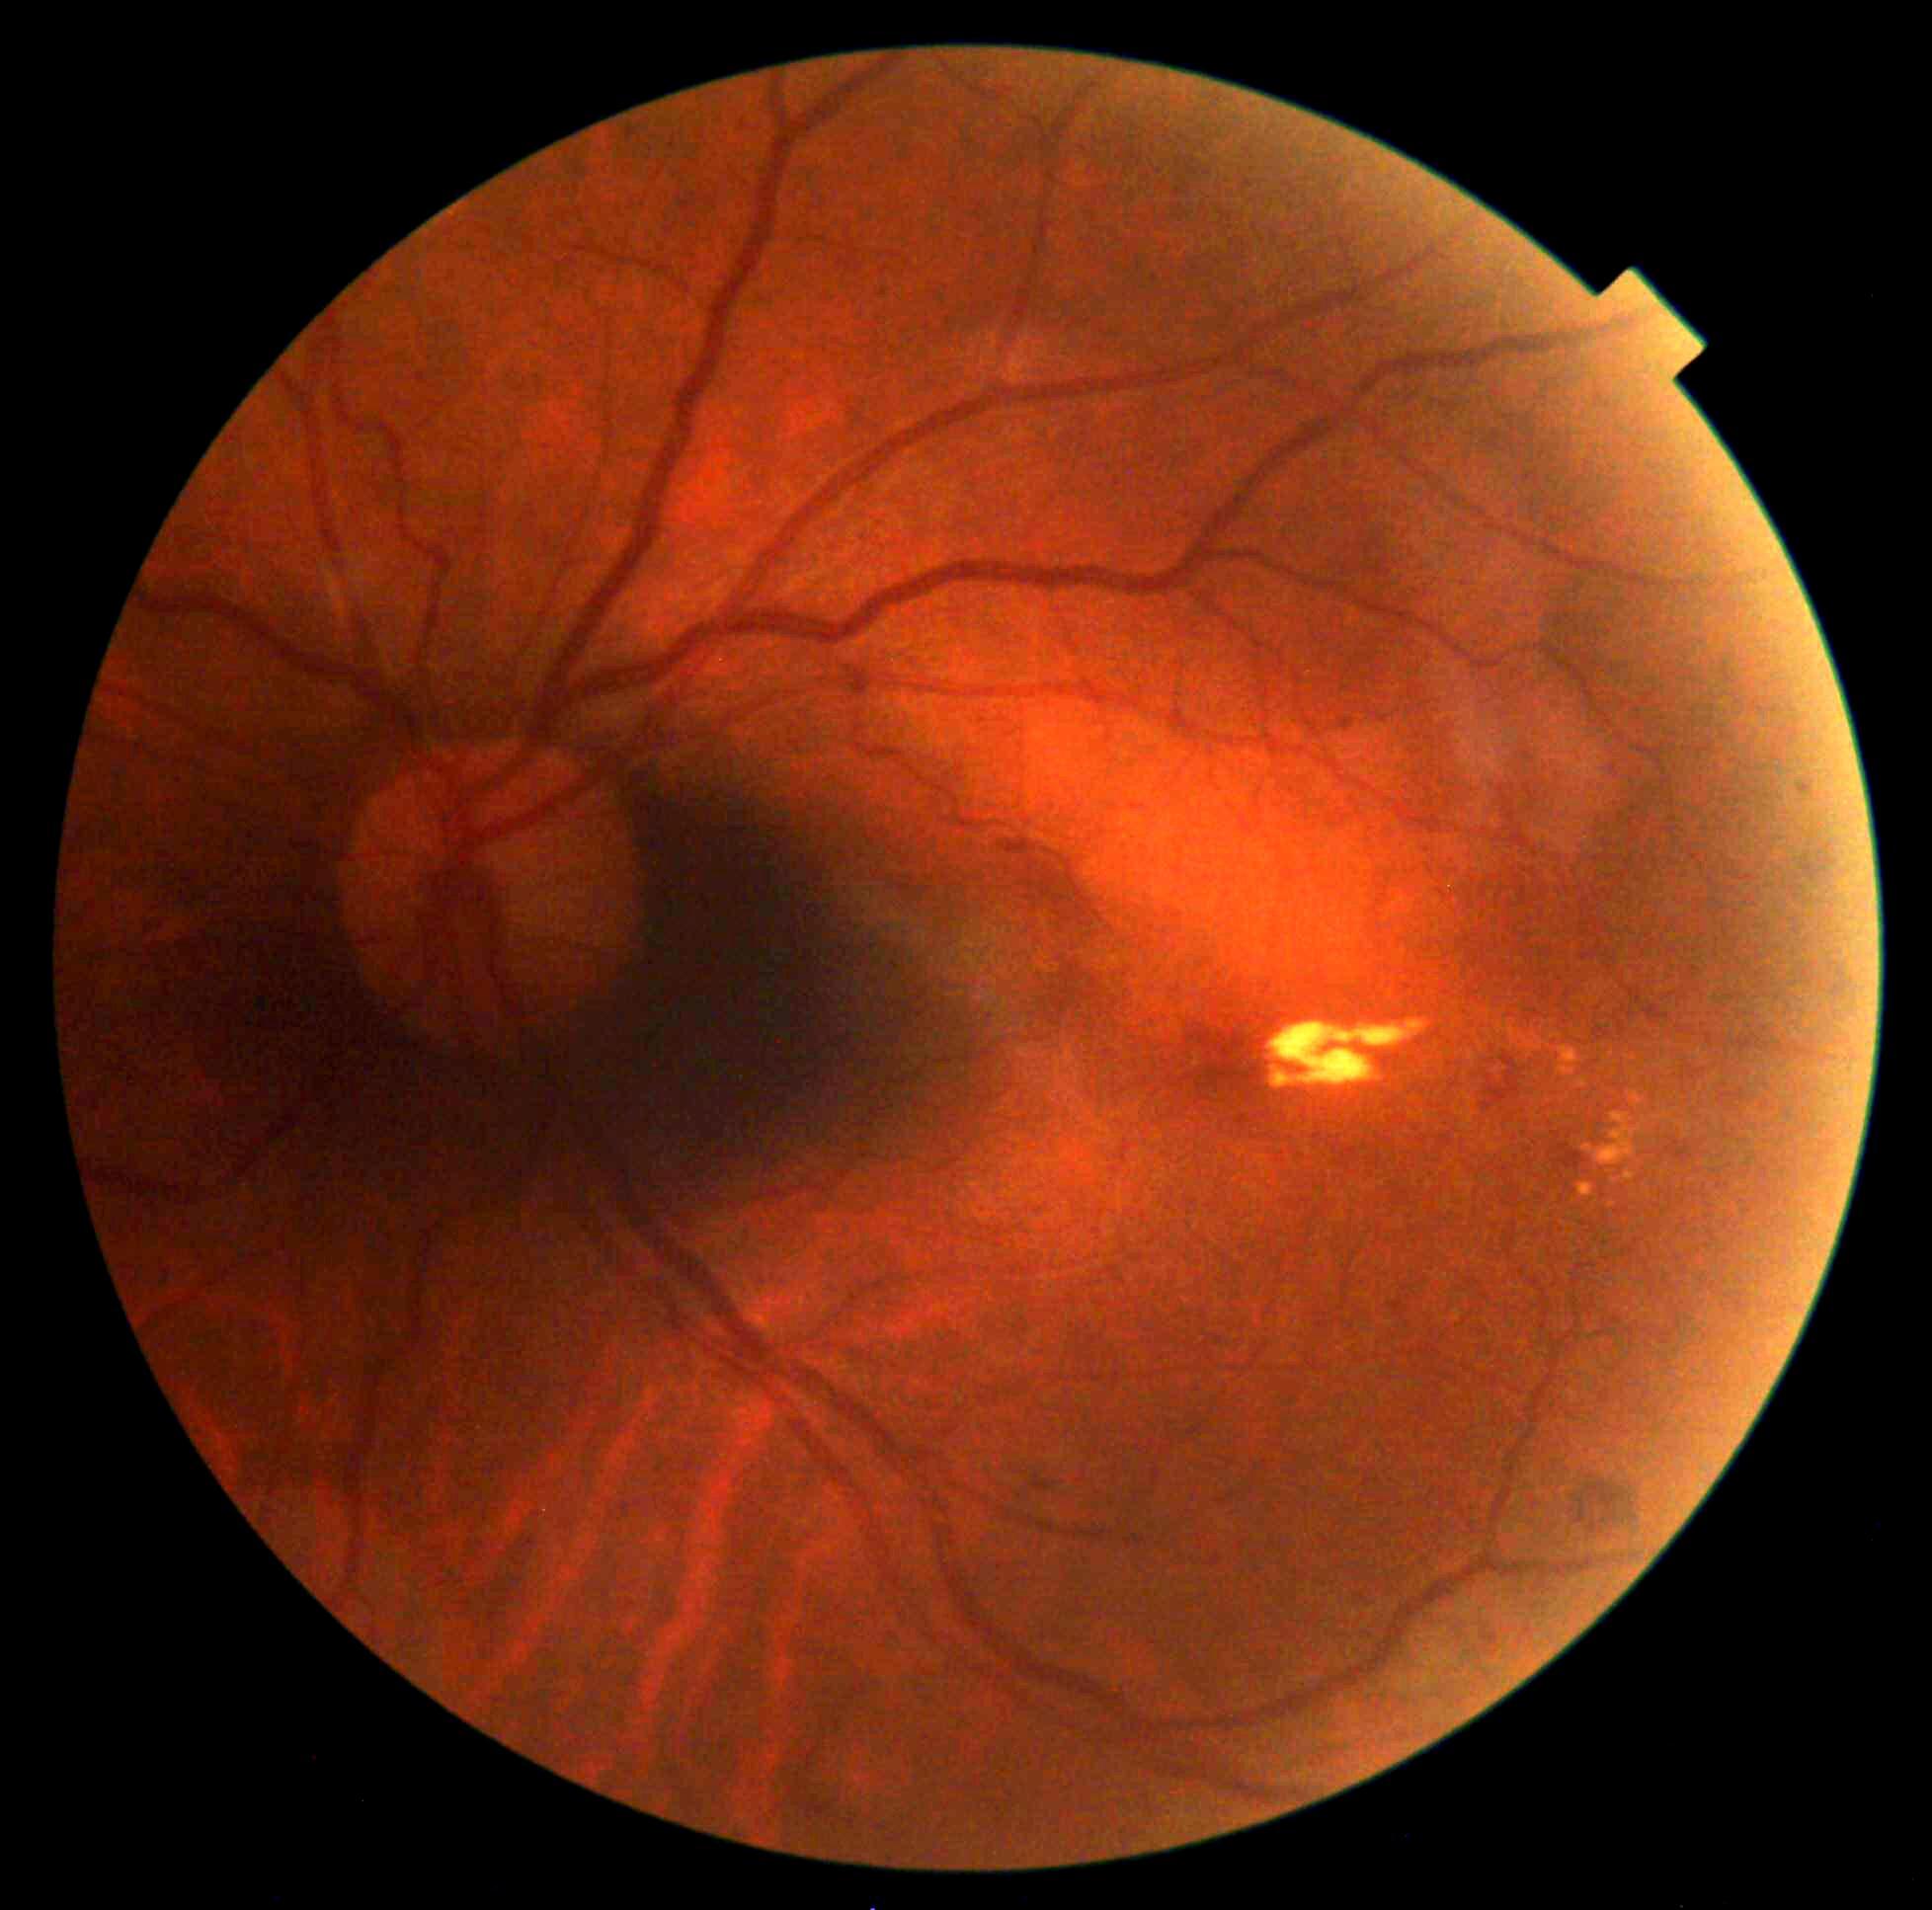
DR grade = 2 (moderate NPDR), DR class = non-proliferative diabetic retinopathy.